Infant wide-field retinal image; 1240x1240
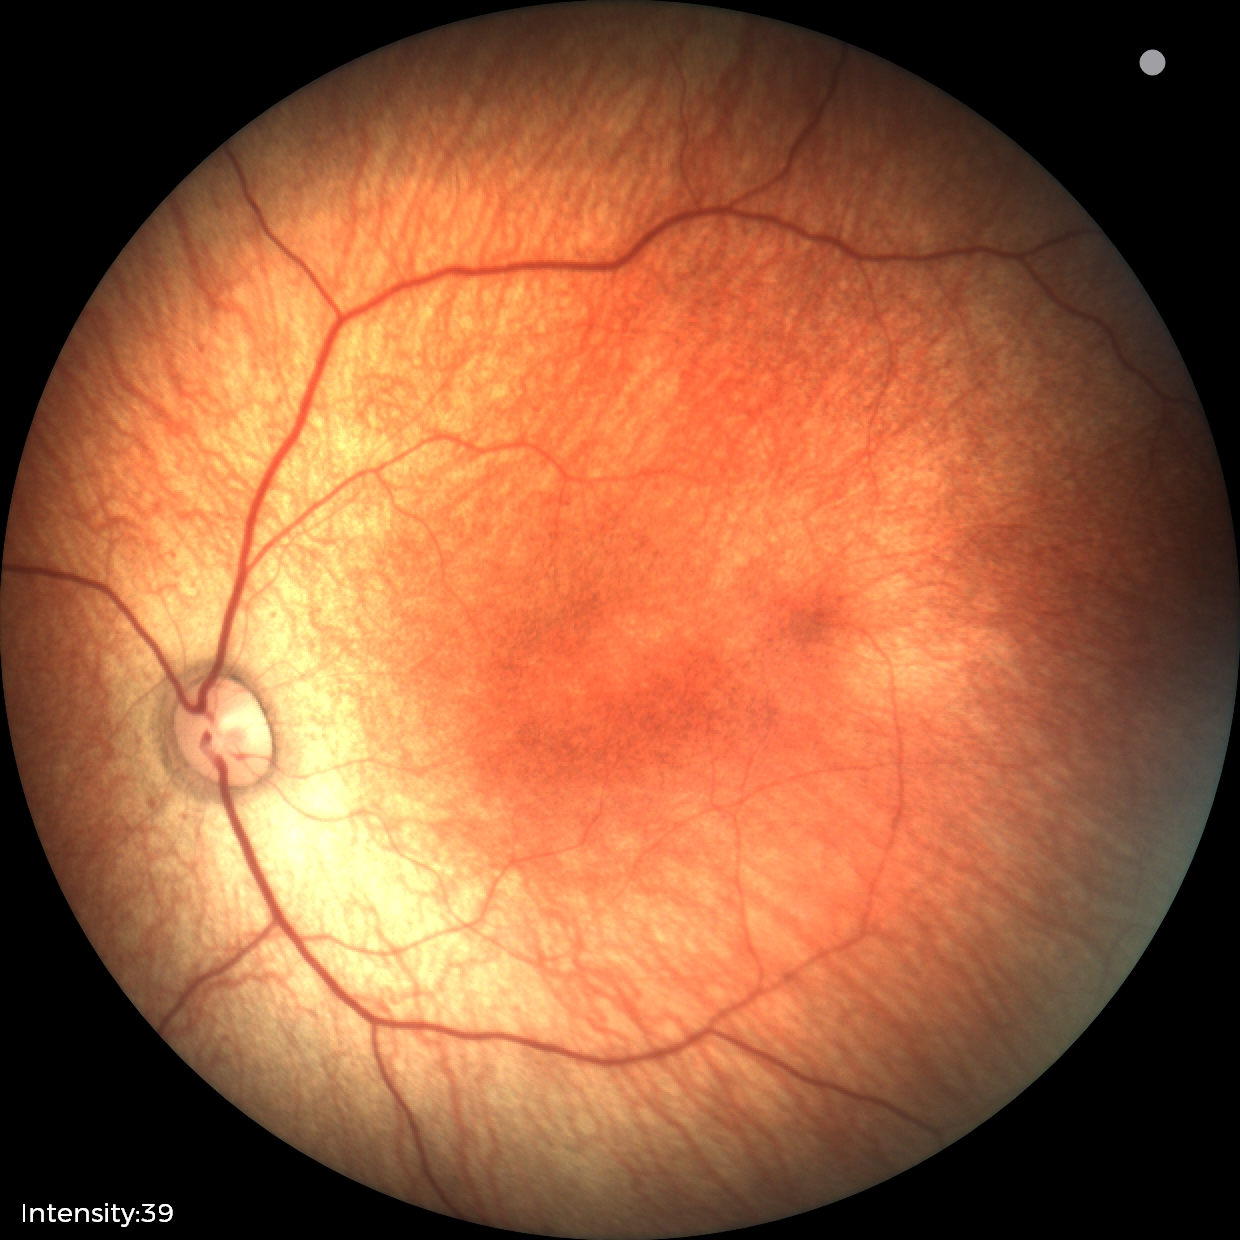
No retinal pathology identified on screening.